2352x1568 — 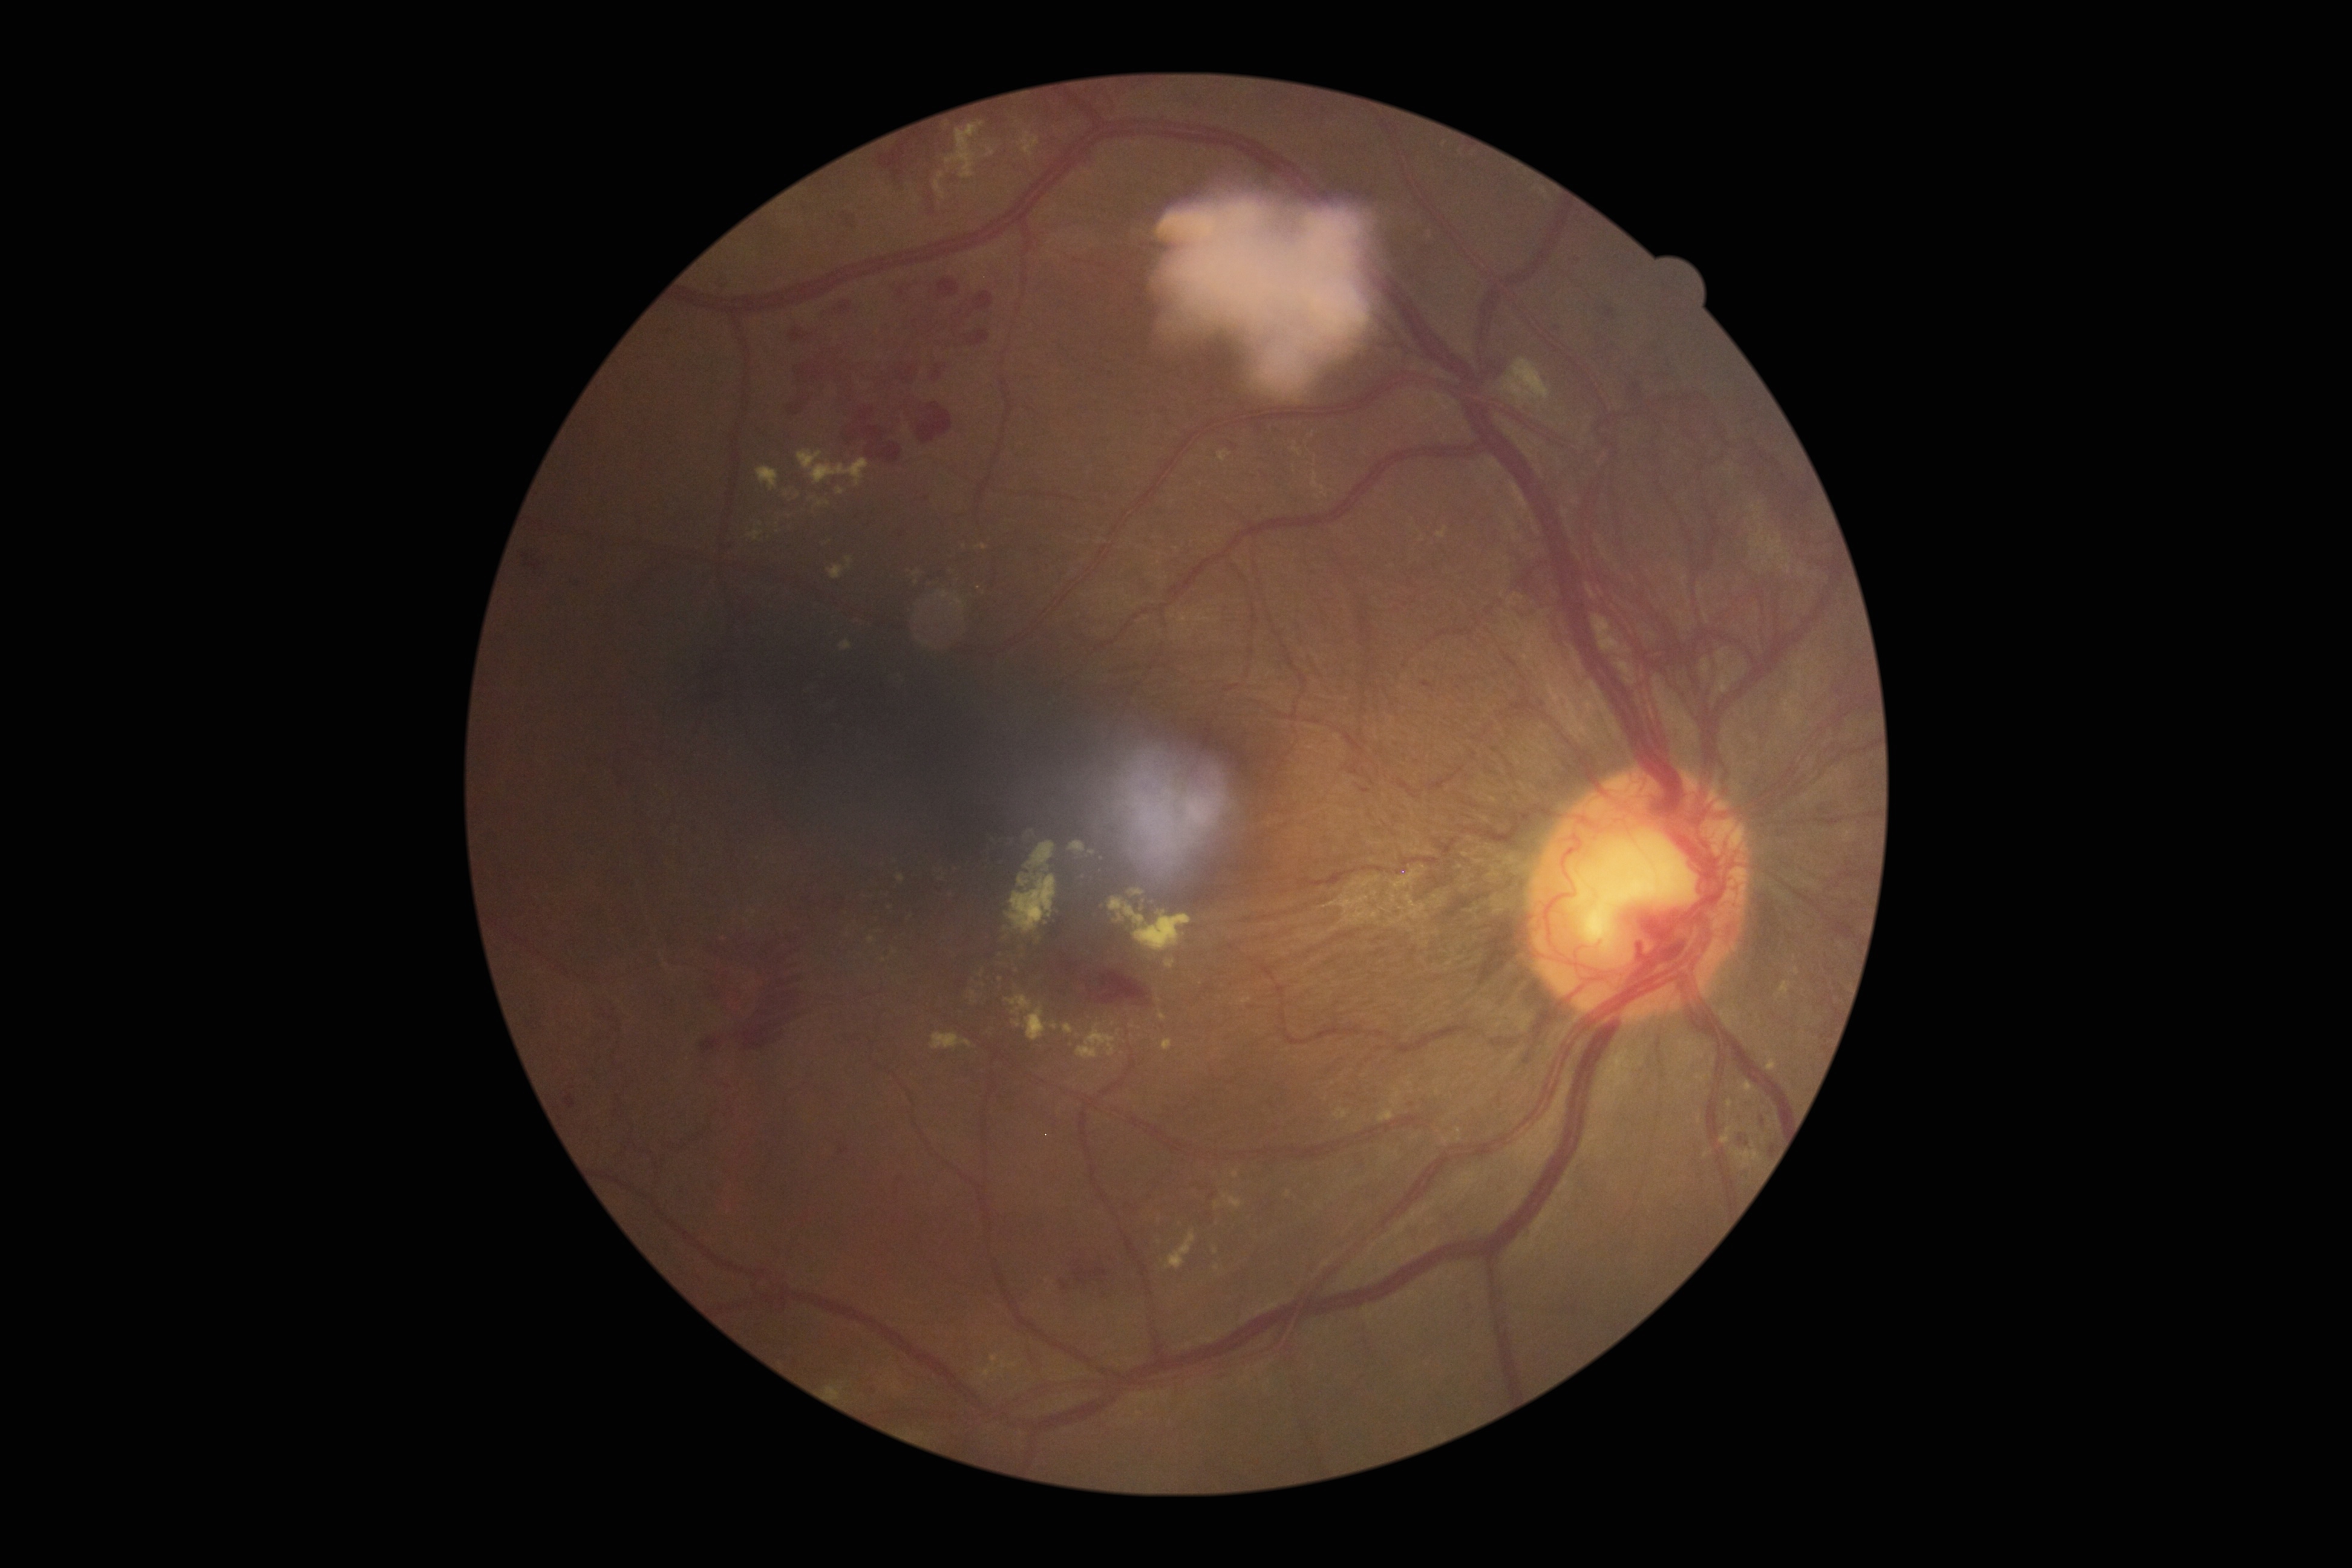
Annotations:
• diabetic retinopathy: grade 4 (PDR)